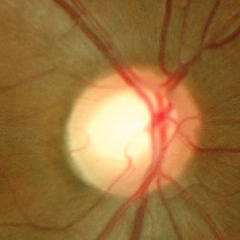

The image shows no glaucomatous changes.